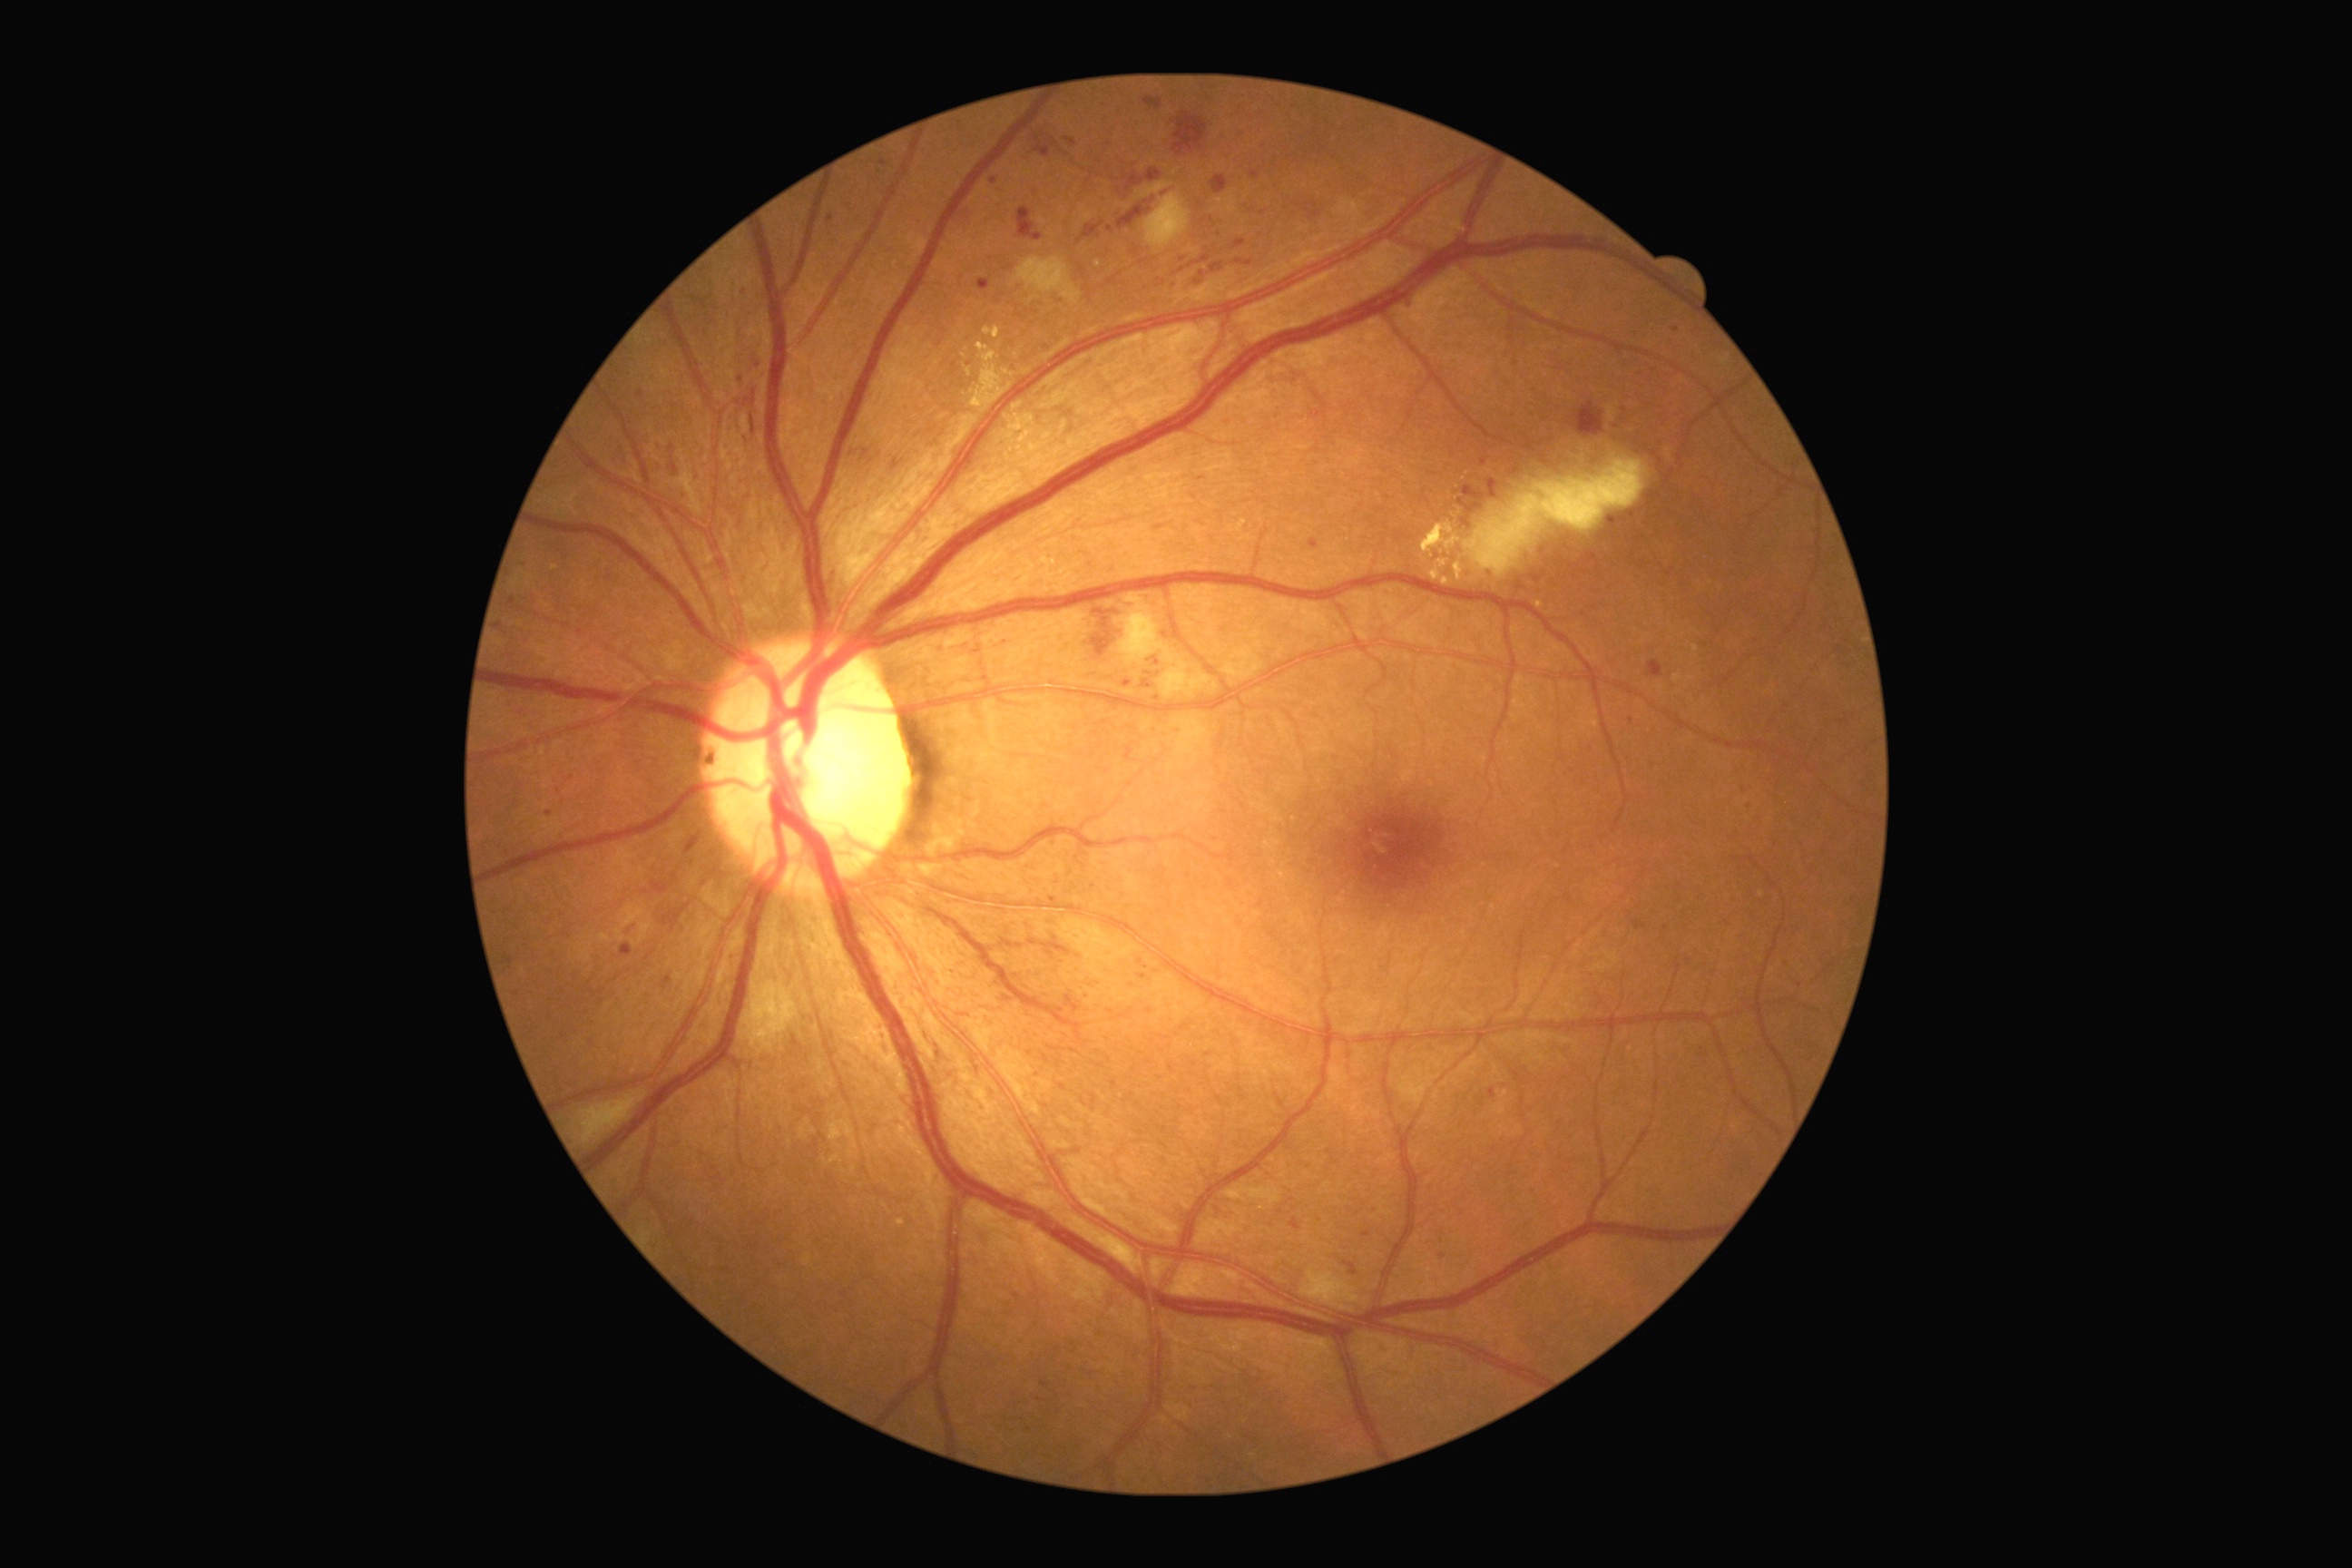 Diabetic retinopathy grade is 2 (moderate NPDR). DR class: non-proliferative diabetic retinopathy.